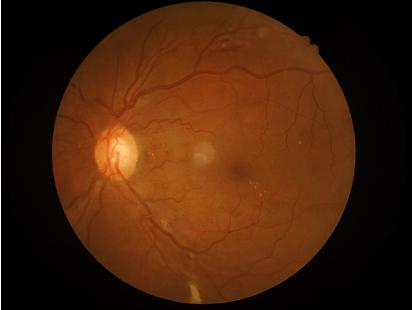

{"overall_quality": "good", "clarity": "good", "illumination": "satisfactory"}